848 x 848 pixels; 45° FOV; posterior pole color fundus photograph — 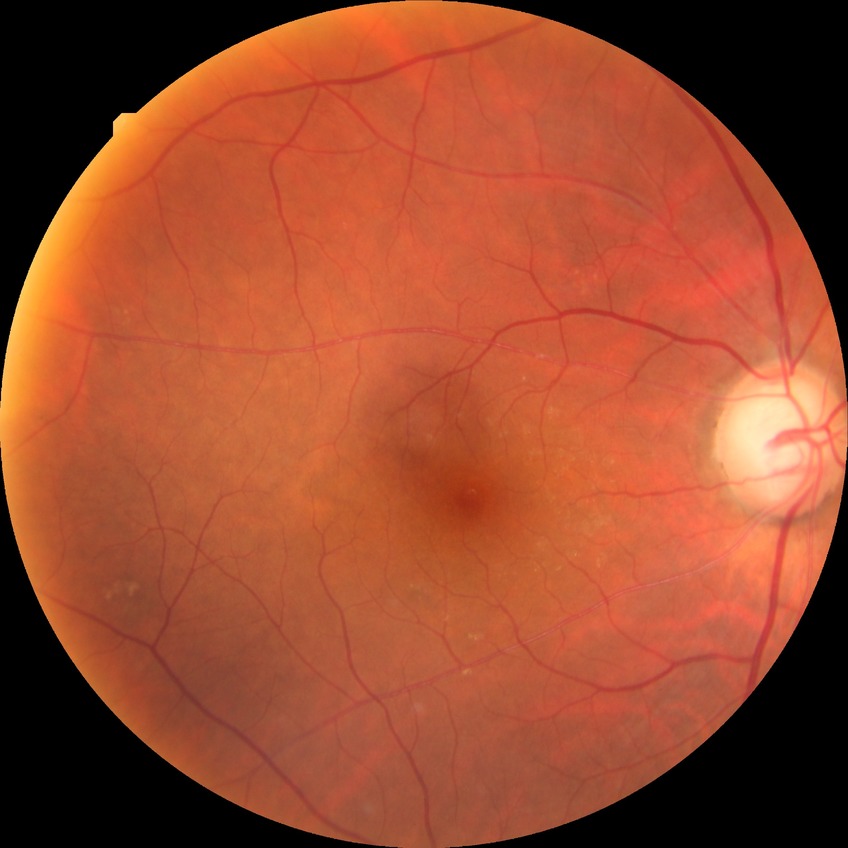
Diabetic retinopathy (DR) is NDR (no diabetic retinopathy).